45° field of view.
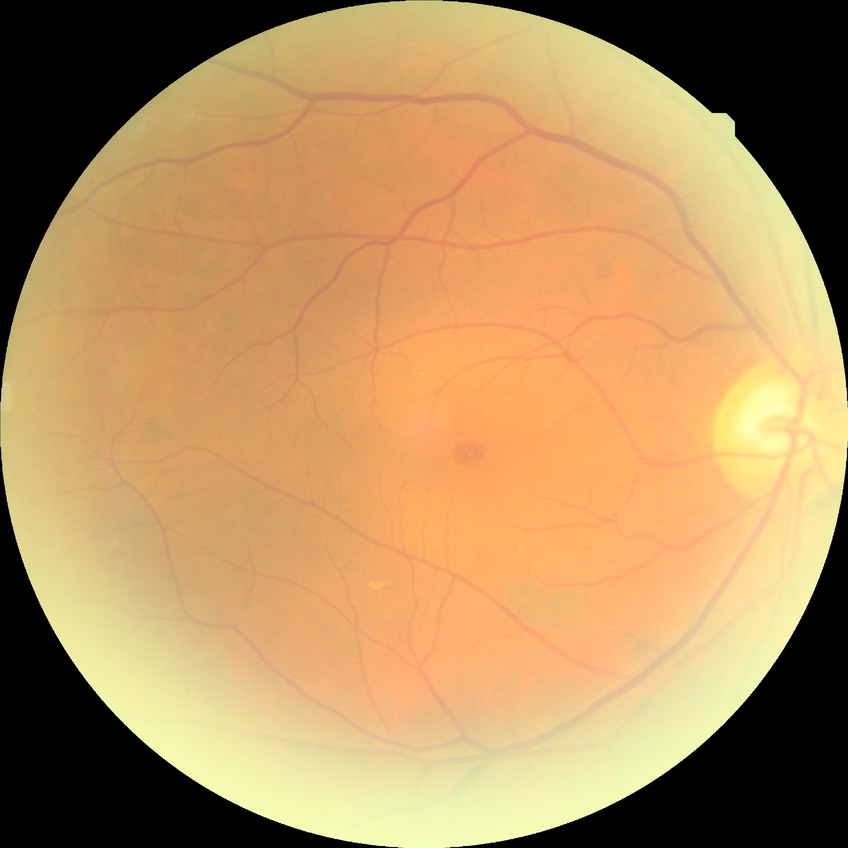 Diabetic retinopathy (DR) is NDR (no diabetic retinopathy).